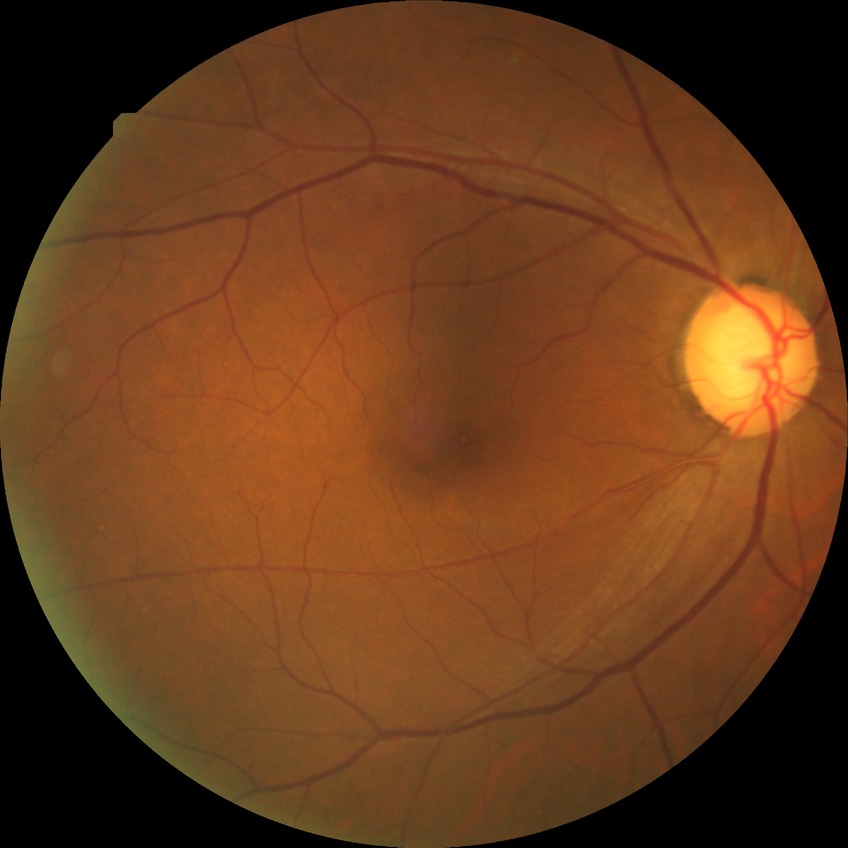 Assessment:
* retinopathy stage: proliferative diabetic retinopathy